FOV: 45 degrees · image size 2346x1568 — 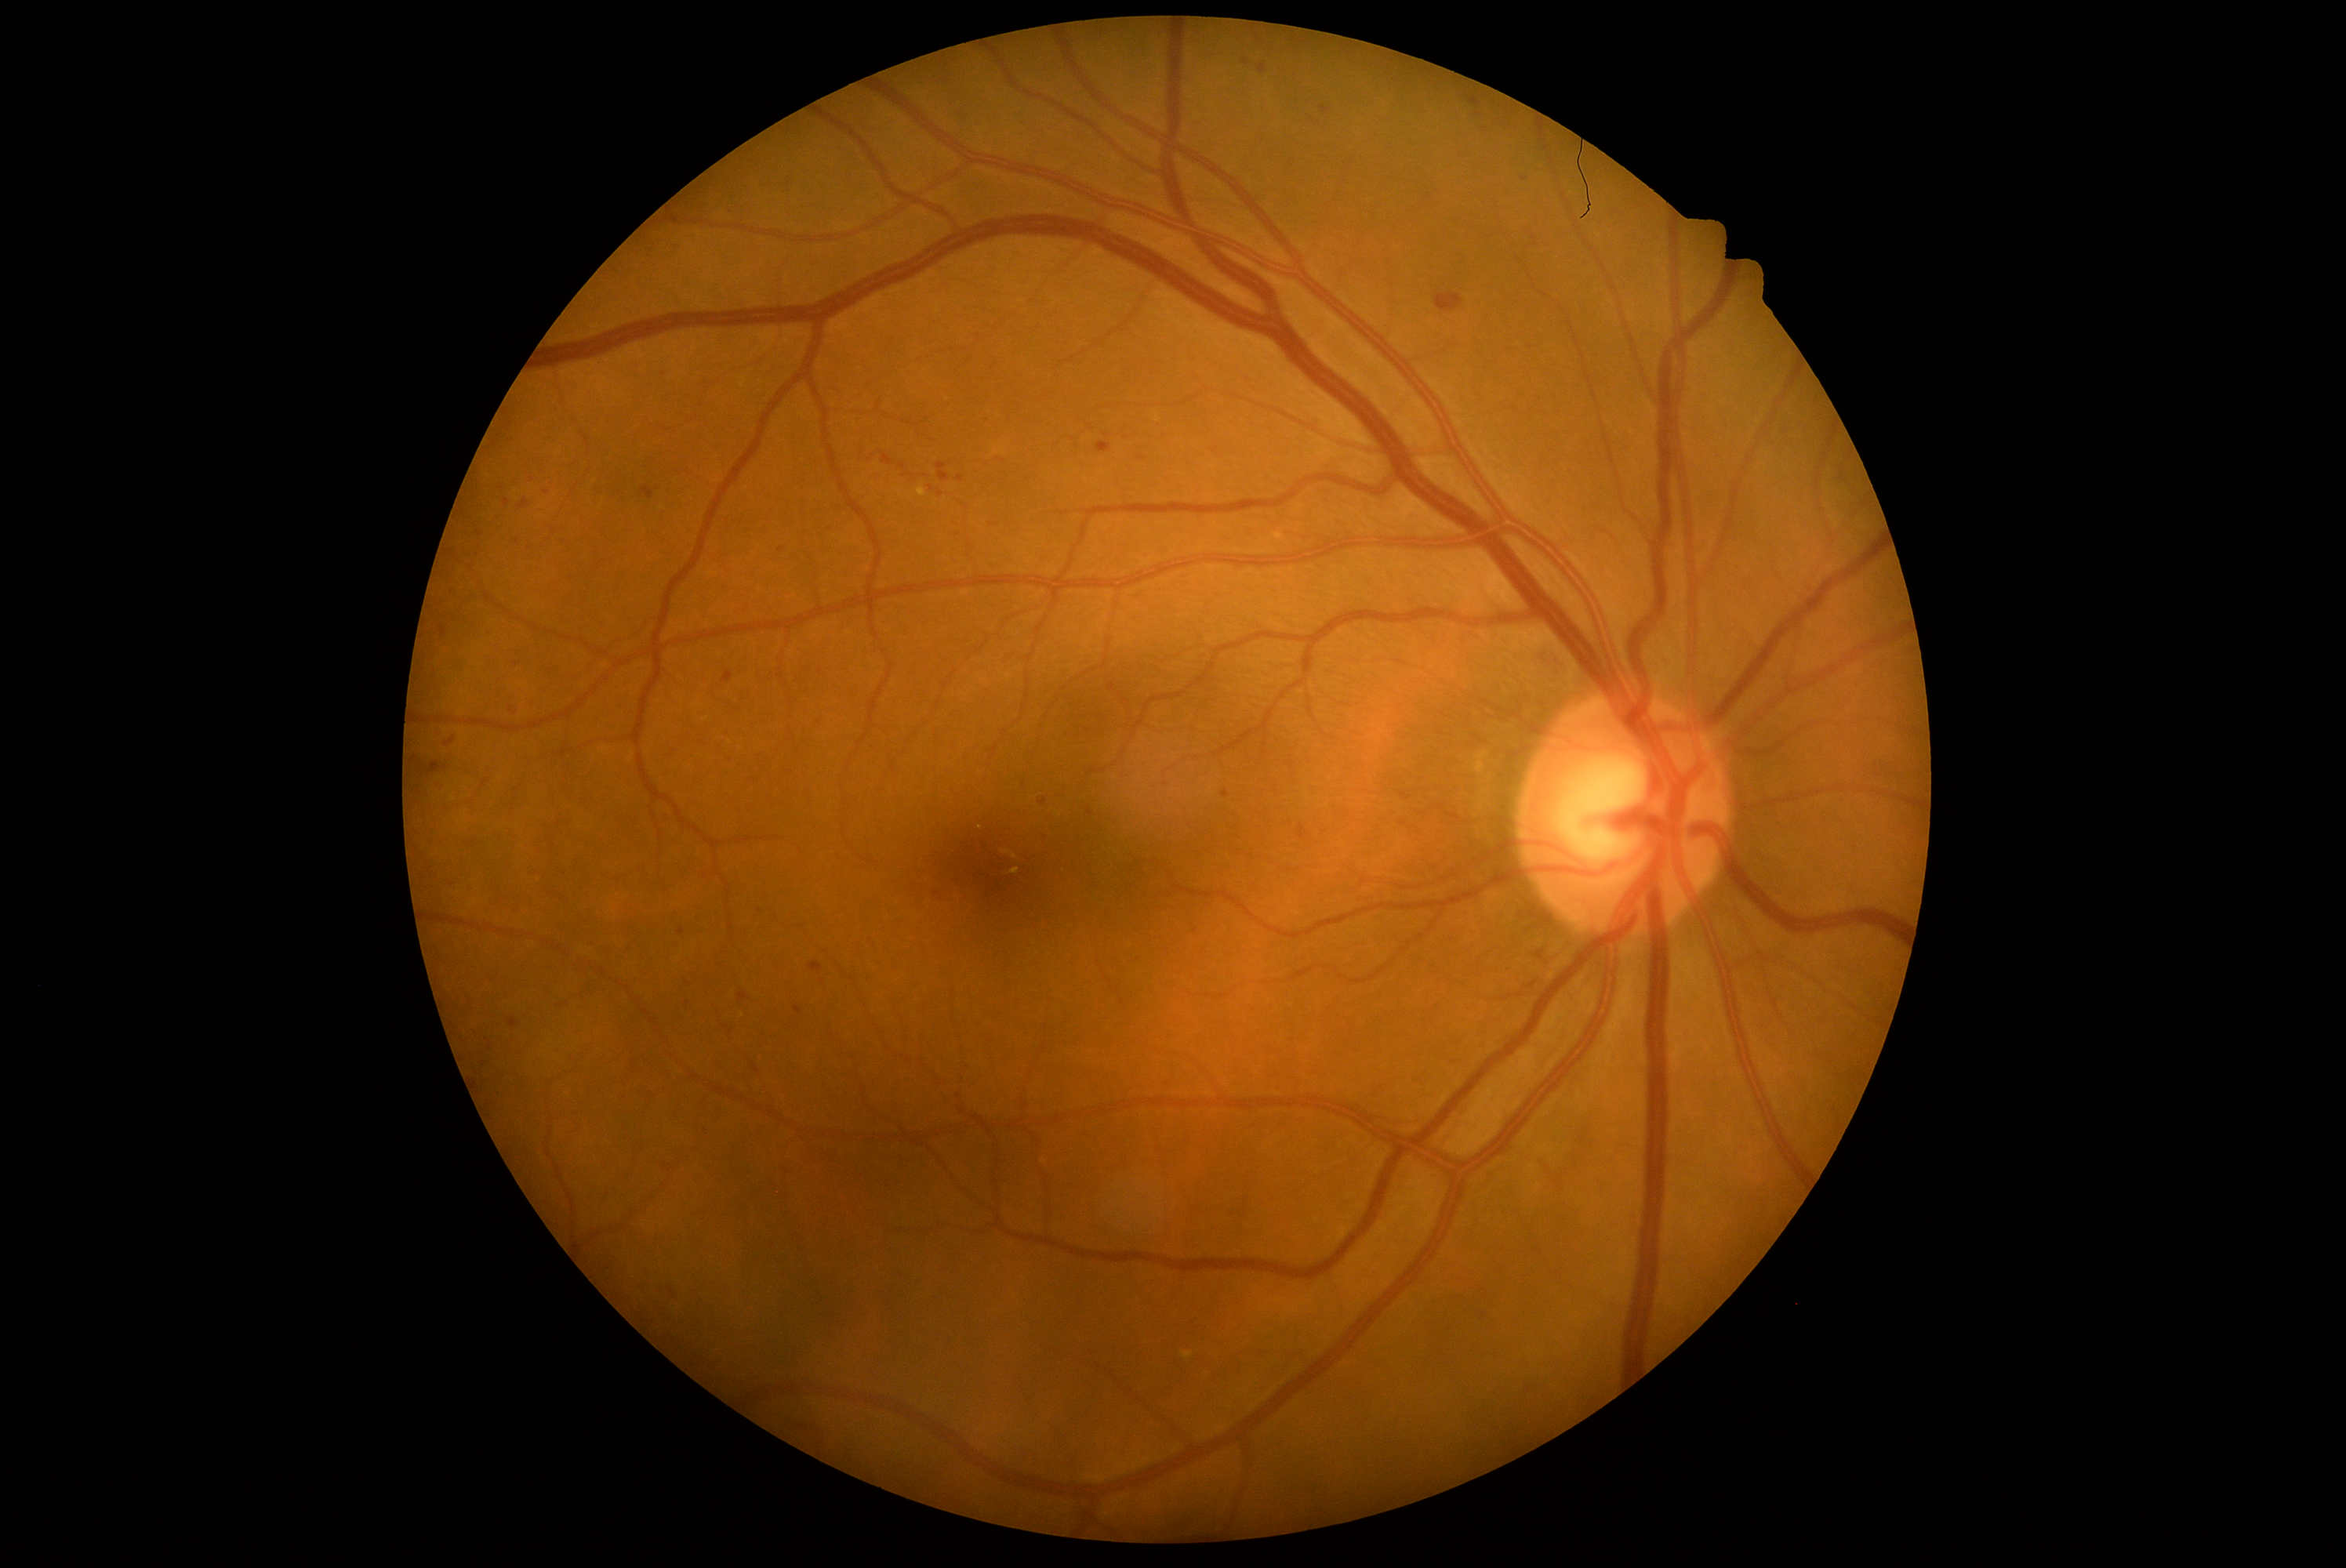 Diabetic retinopathy: grade 2 (moderate NPDR)
A subset of detected lesions:
hard exudates: bbox(917, 488, 926, 496)
soft exudates: none identified
microaneurysms: none identified
hemorrhages (subset): bbox(659, 940, 680, 951); bbox(1467, 111, 1486, 122); bbox(791, 1423, 819, 1434); bbox(451, 590, 457, 598); bbox(700, 1125, 711, 1136); bbox(1039, 799, 1047, 807); bbox(432, 728, 445, 739); bbox(641, 1268, 652, 1283); bbox(721, 730, 732, 739); bbox(1434, 291, 1464, 313); bbox(823, 524, 833, 532); bbox(663, 1164, 672, 1172)
Small hemorrhages approximately at (530,549); (781,551); (937,894); (760,911); (1102,718); (517,664)